Wide-field fundus image from infant ROP screening. Phoenix ICON, 100° FOV
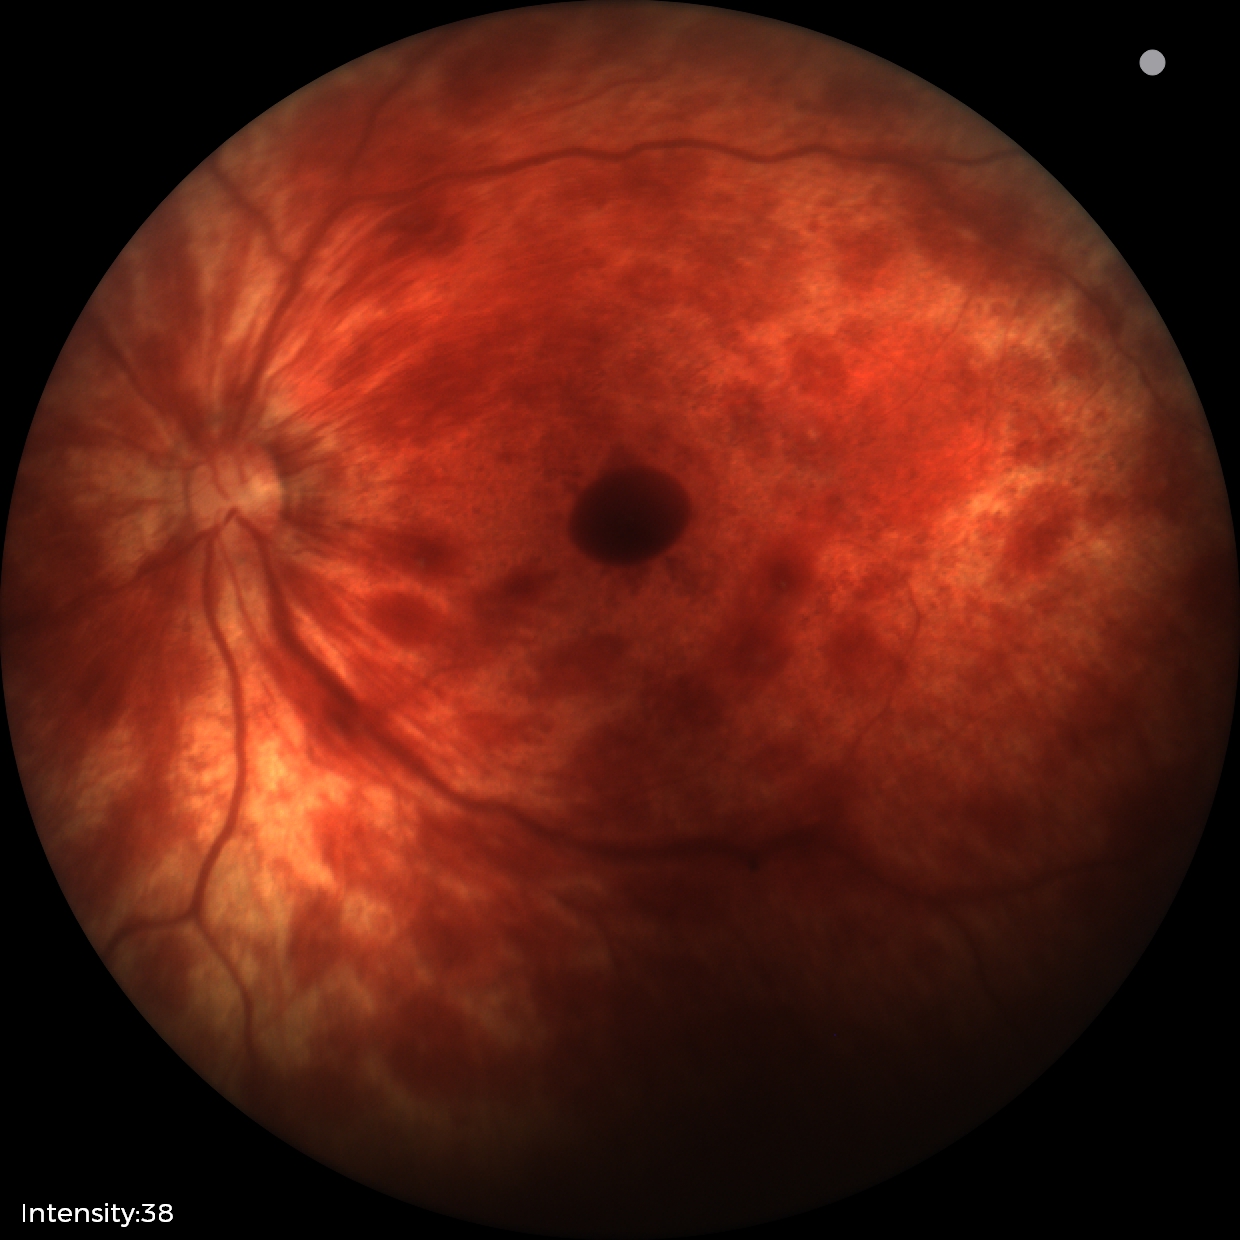 Series diagnosed as retinal hemorrhages.